1240x1240px. Infant wide-field retinal image. Captured with the Phoenix ICON (100° field of view) — 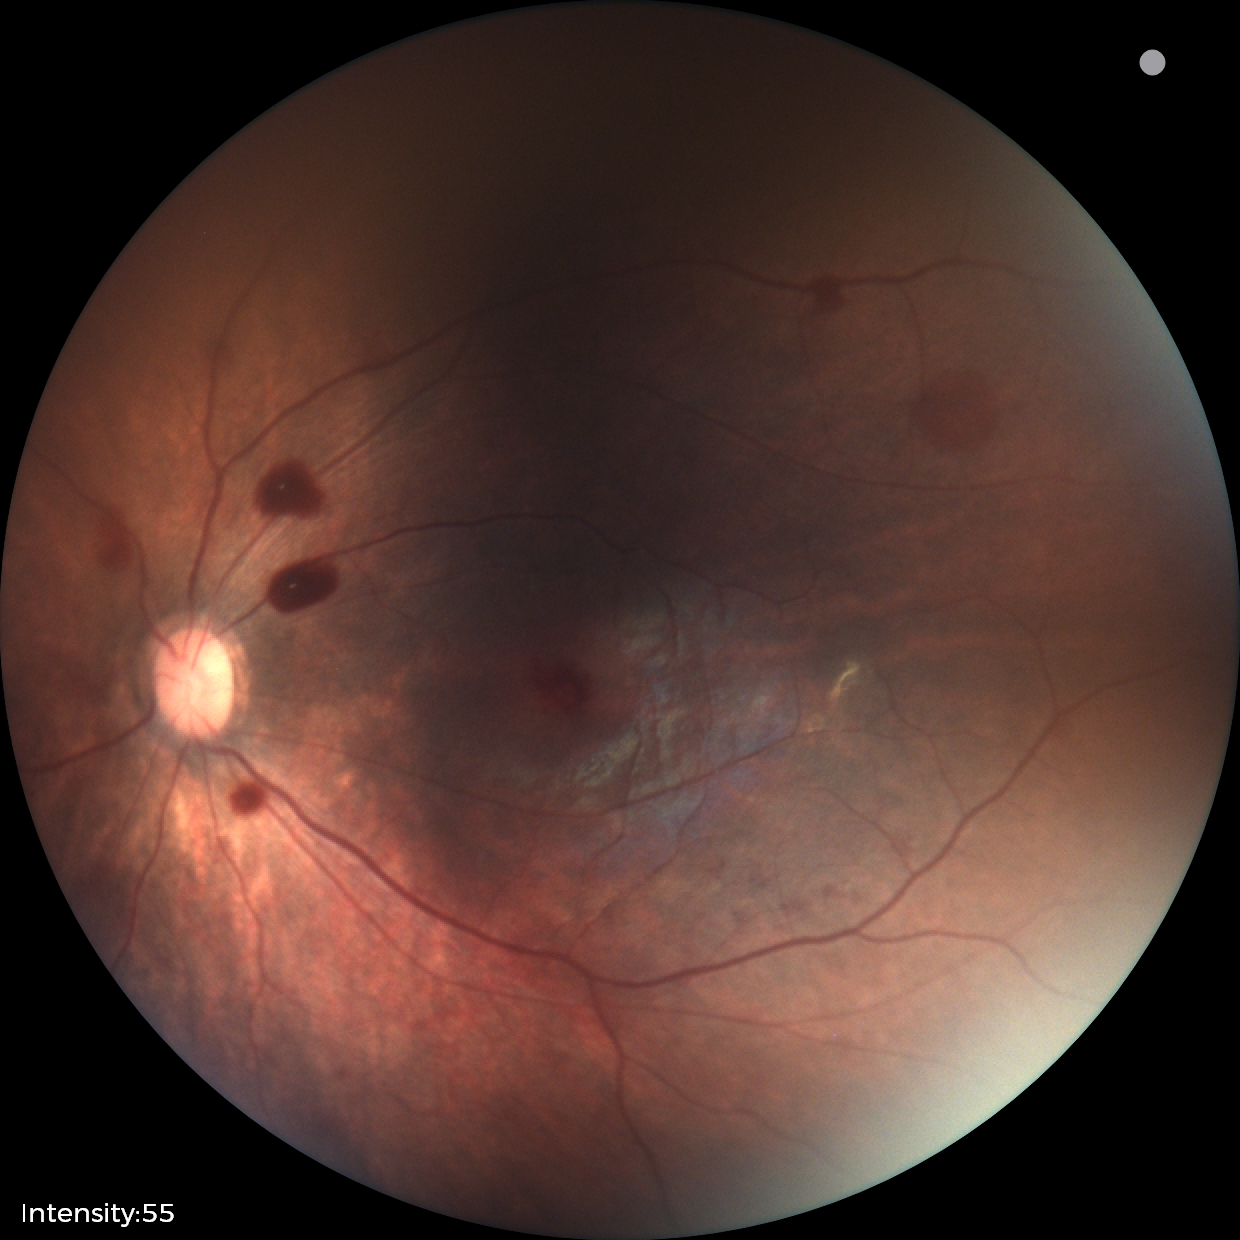
Q: What is the screening diagnosis?
A: retinal hemorrhages